Color fundus photograph, 2212 by 1659 pixels, FOV: 45 degrees — 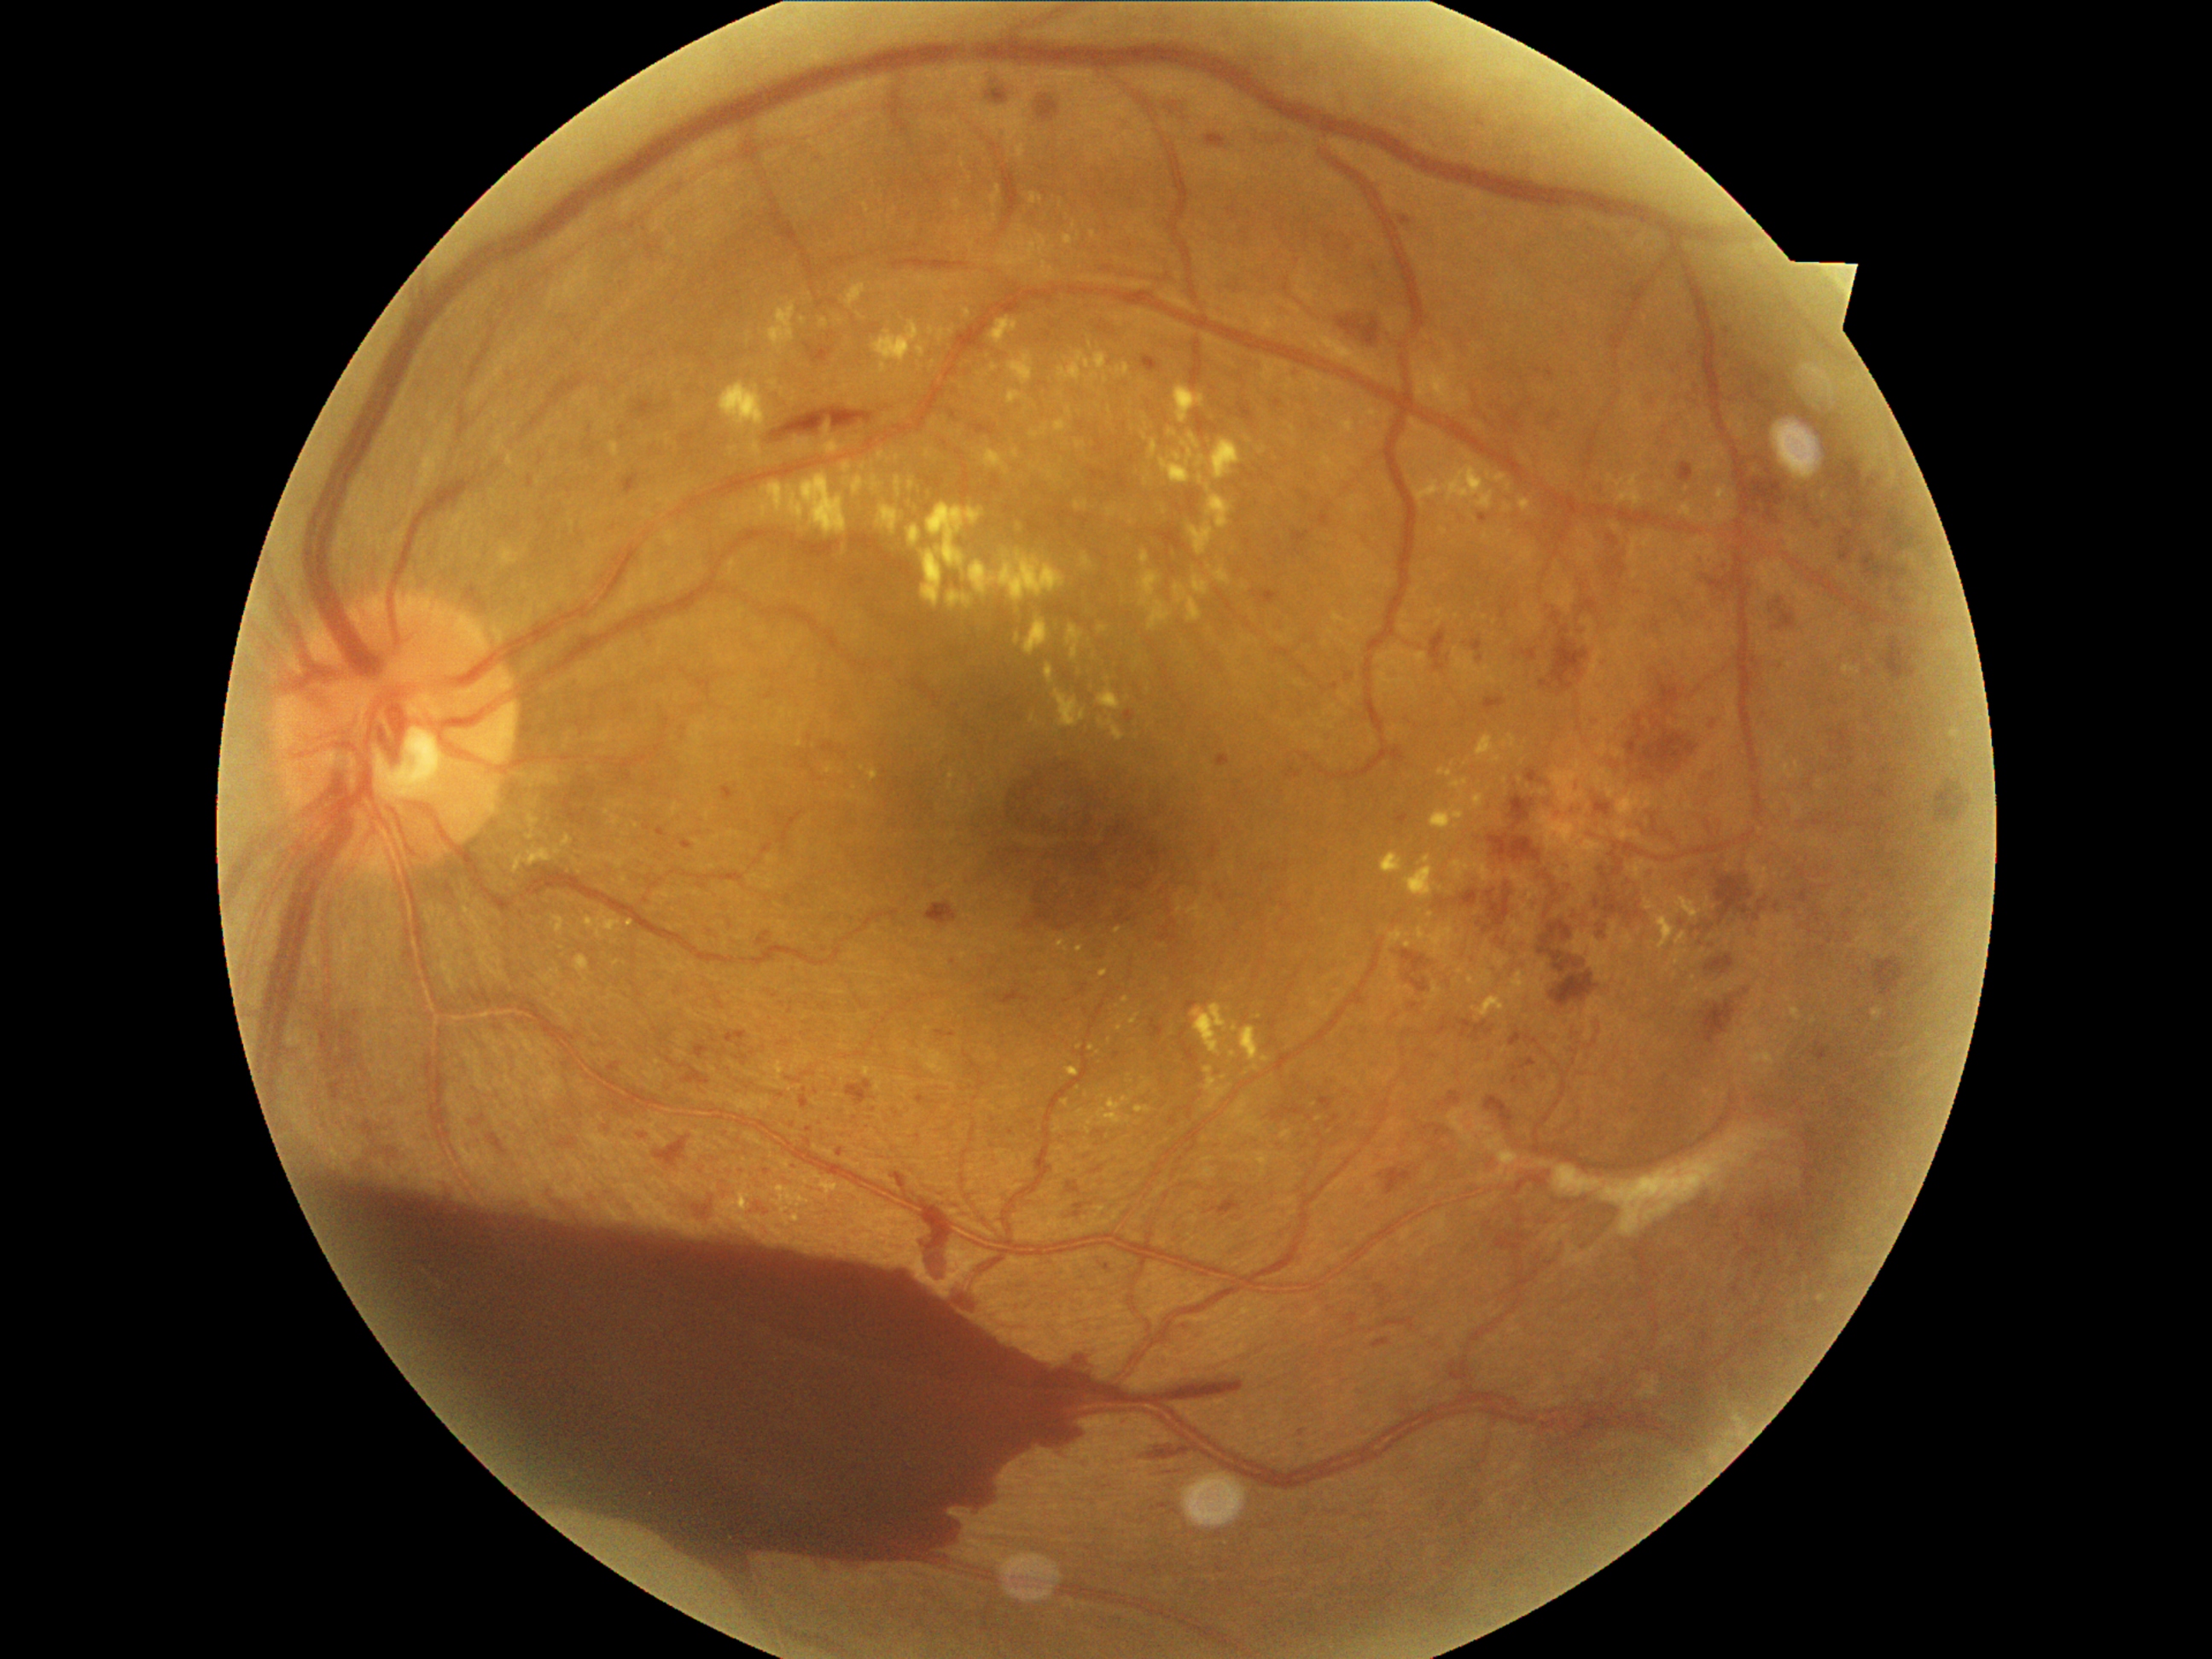

{"partial":true,"dr_grade":4,"dr_grade_name":"PDR","lesions":{"ex":[[525,810,540,825],[1469,511,1477,521],[801,1175,810,1187],[1503,735,1516,748],[1873,1010,1883,1022],[1619,474,1644,508],[1240,1027,1269,1071],[1098,718,1126,740],[1037,262,1056,281],[1098,626,1107,634],[1518,499,1530,511],[1607,475,1614,484],[1085,1091,1136,1134]],"ex_small_centers":[[1074,226],[748,335],[1078,237],[826,379],[1120,1028],[1509,533]]}}